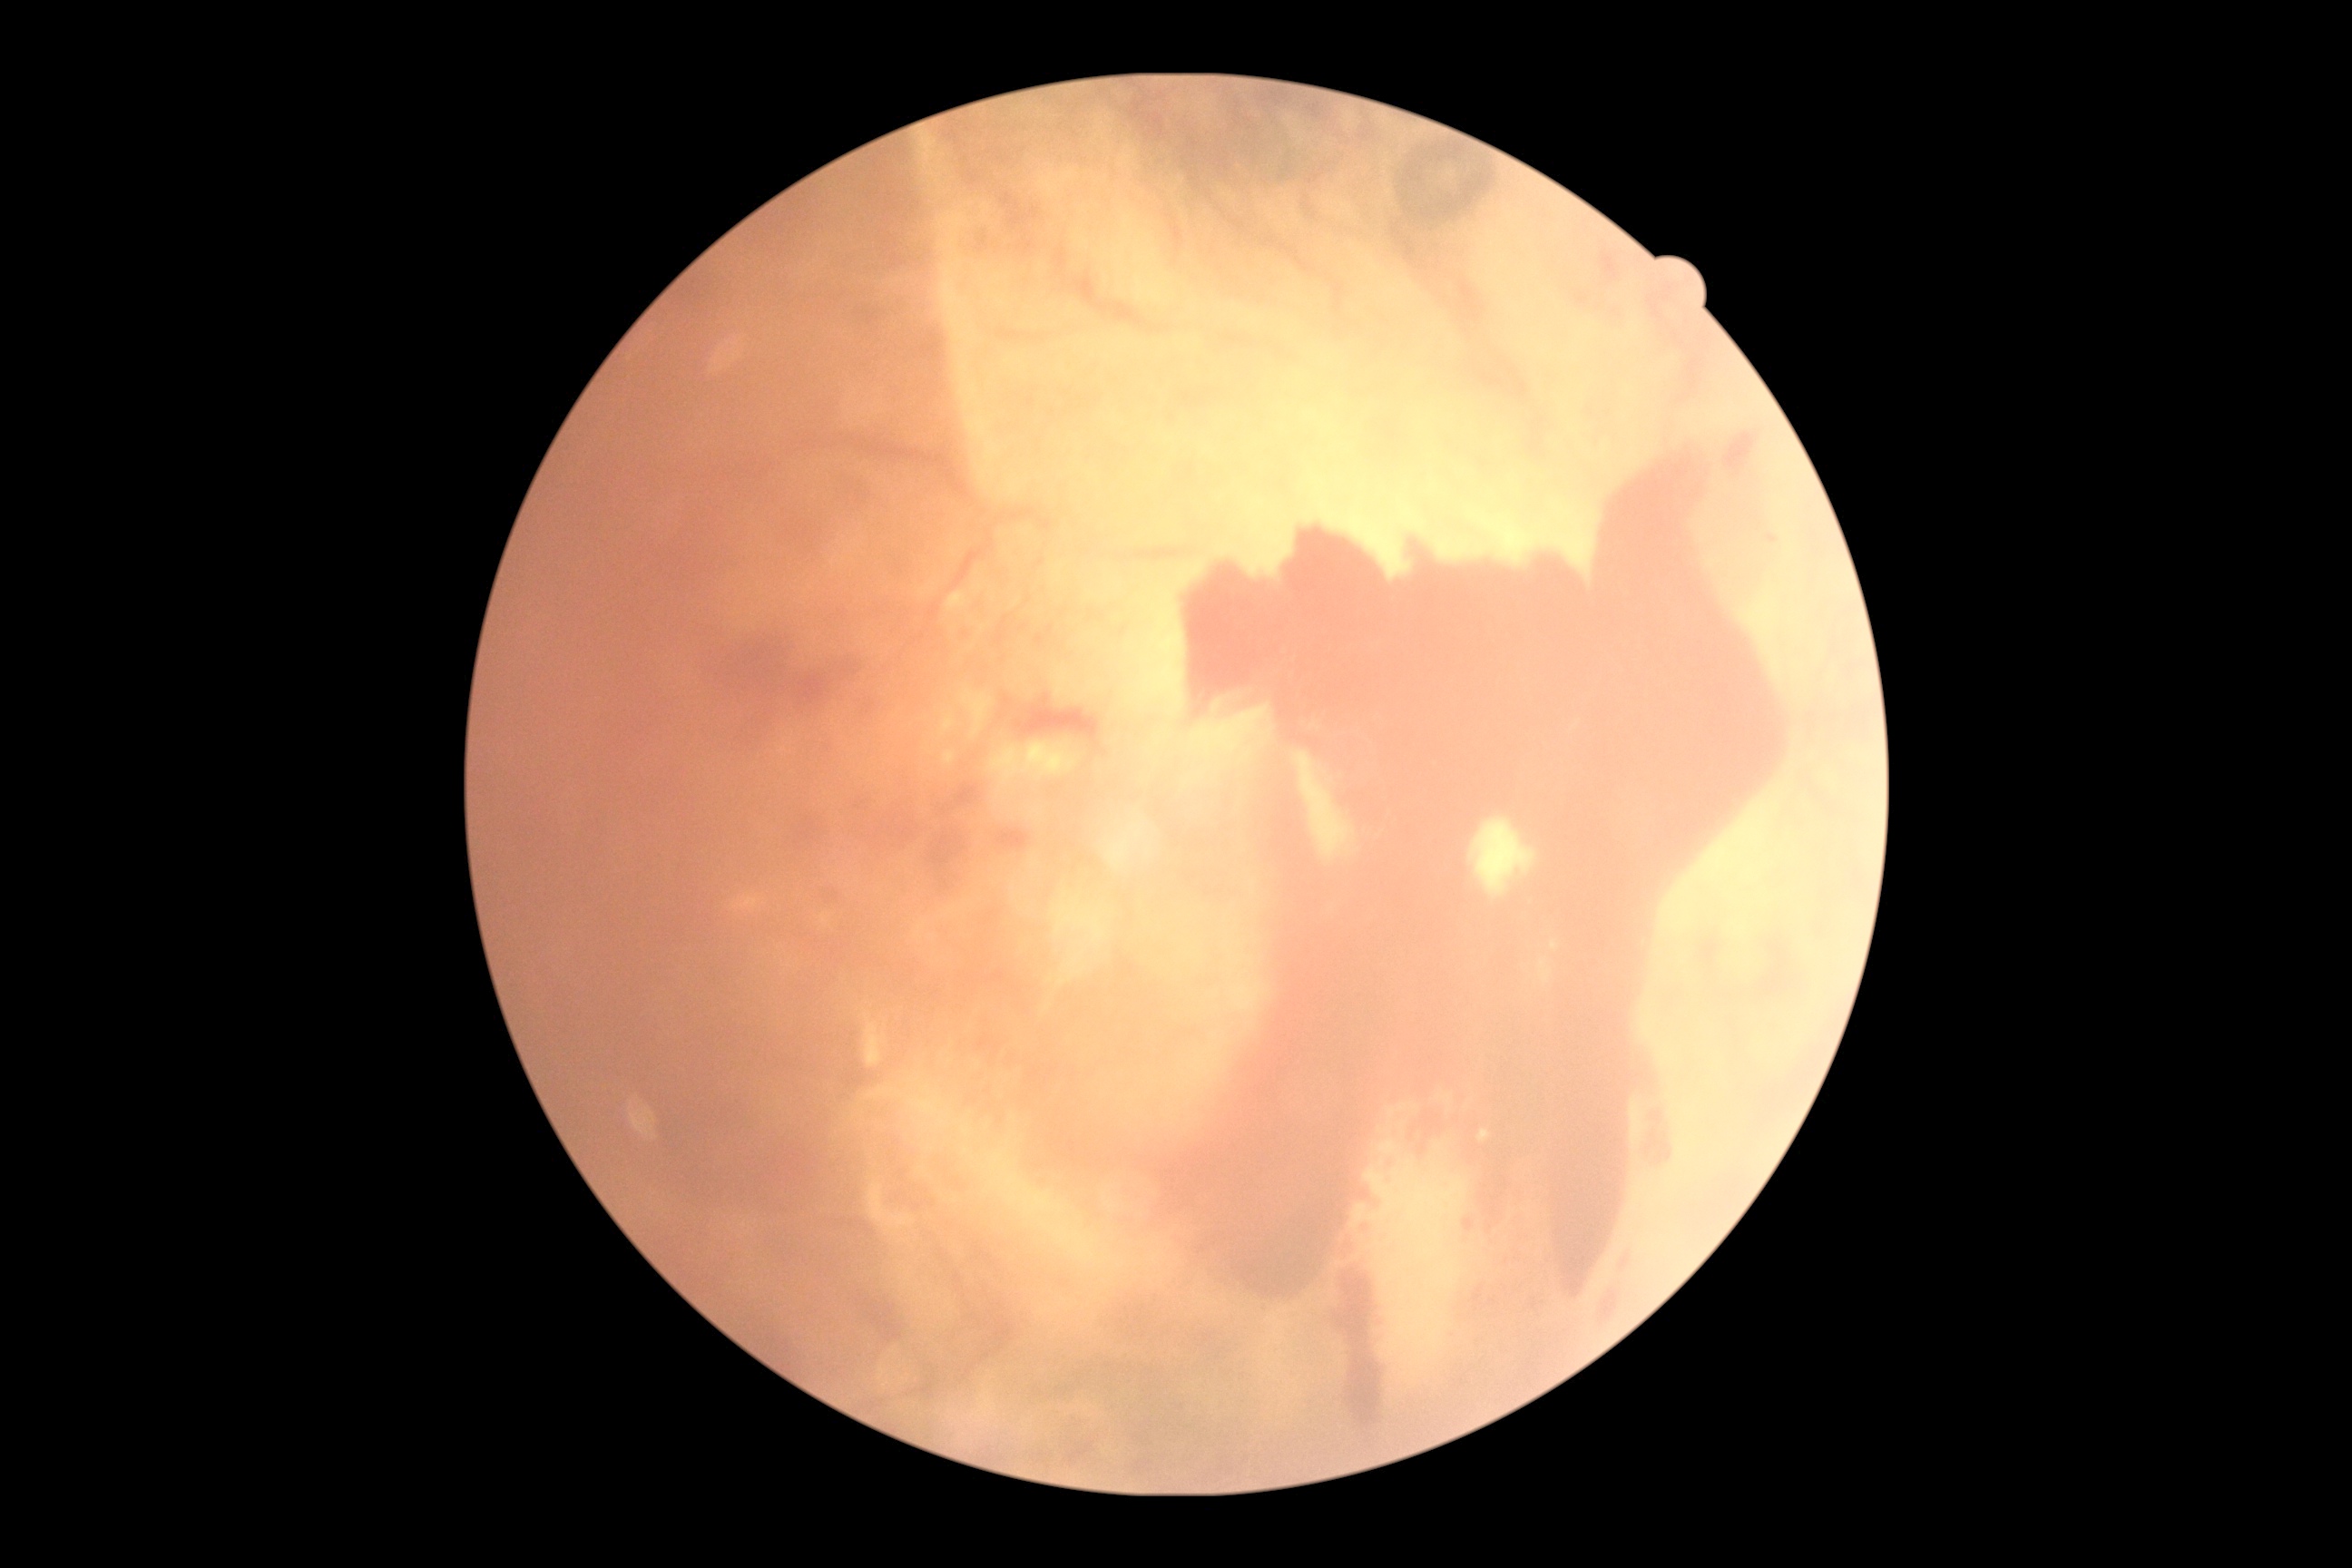 {"dr_category": "proliferative diabetic retinopathy", "dr_grade": "grade 4 (PDR) — neovascularization and/or vitreous/pre-retinal hemorrhage"}